NIDEK AFC-230. DR severity per modified Davis staging
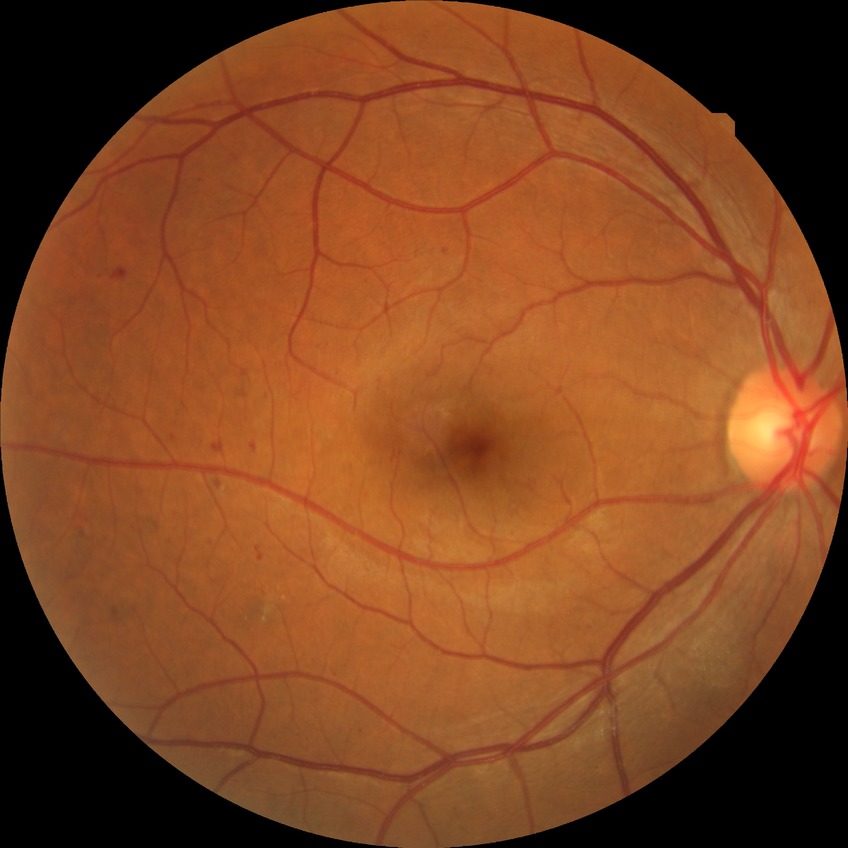 diabetic retinopathy (DR) = simple diabetic retinopathy (SDR)
DR class = non-proliferative diabetic retinopathy